Color fundus photograph.
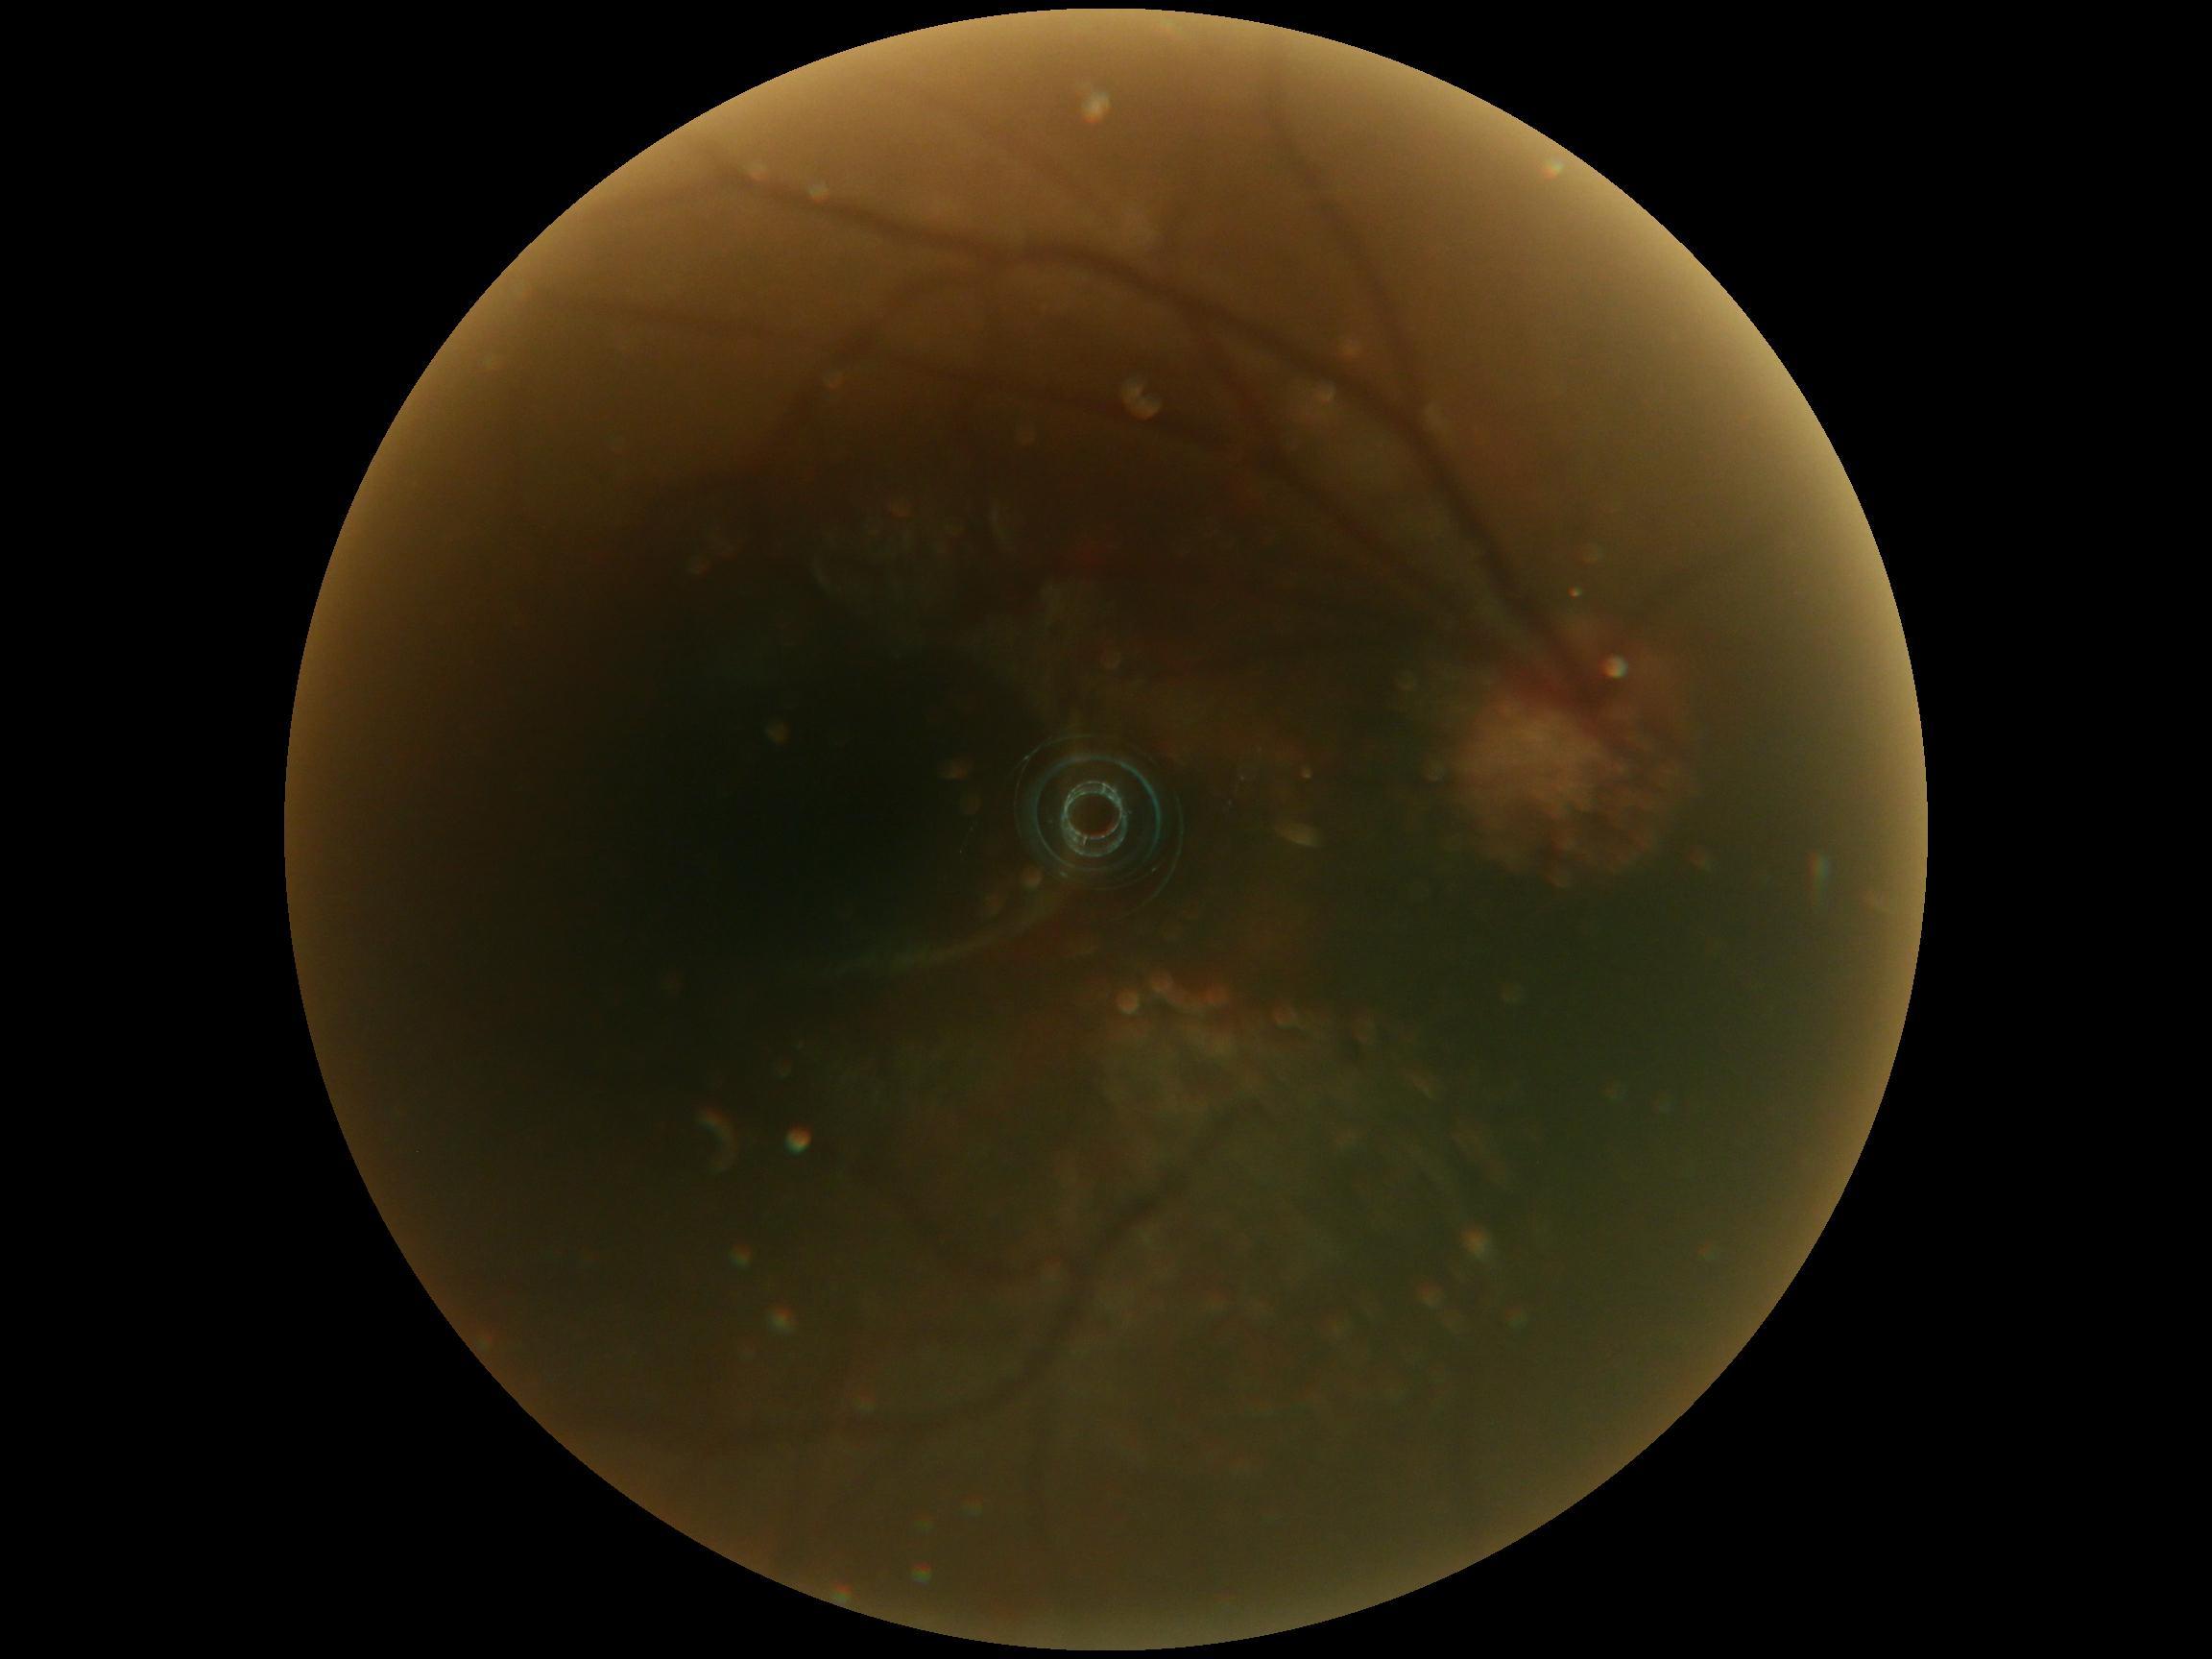
DR severity is ungradable.
Quality too poor to assess for DR.